45° field of view. Image size 2212x1659:
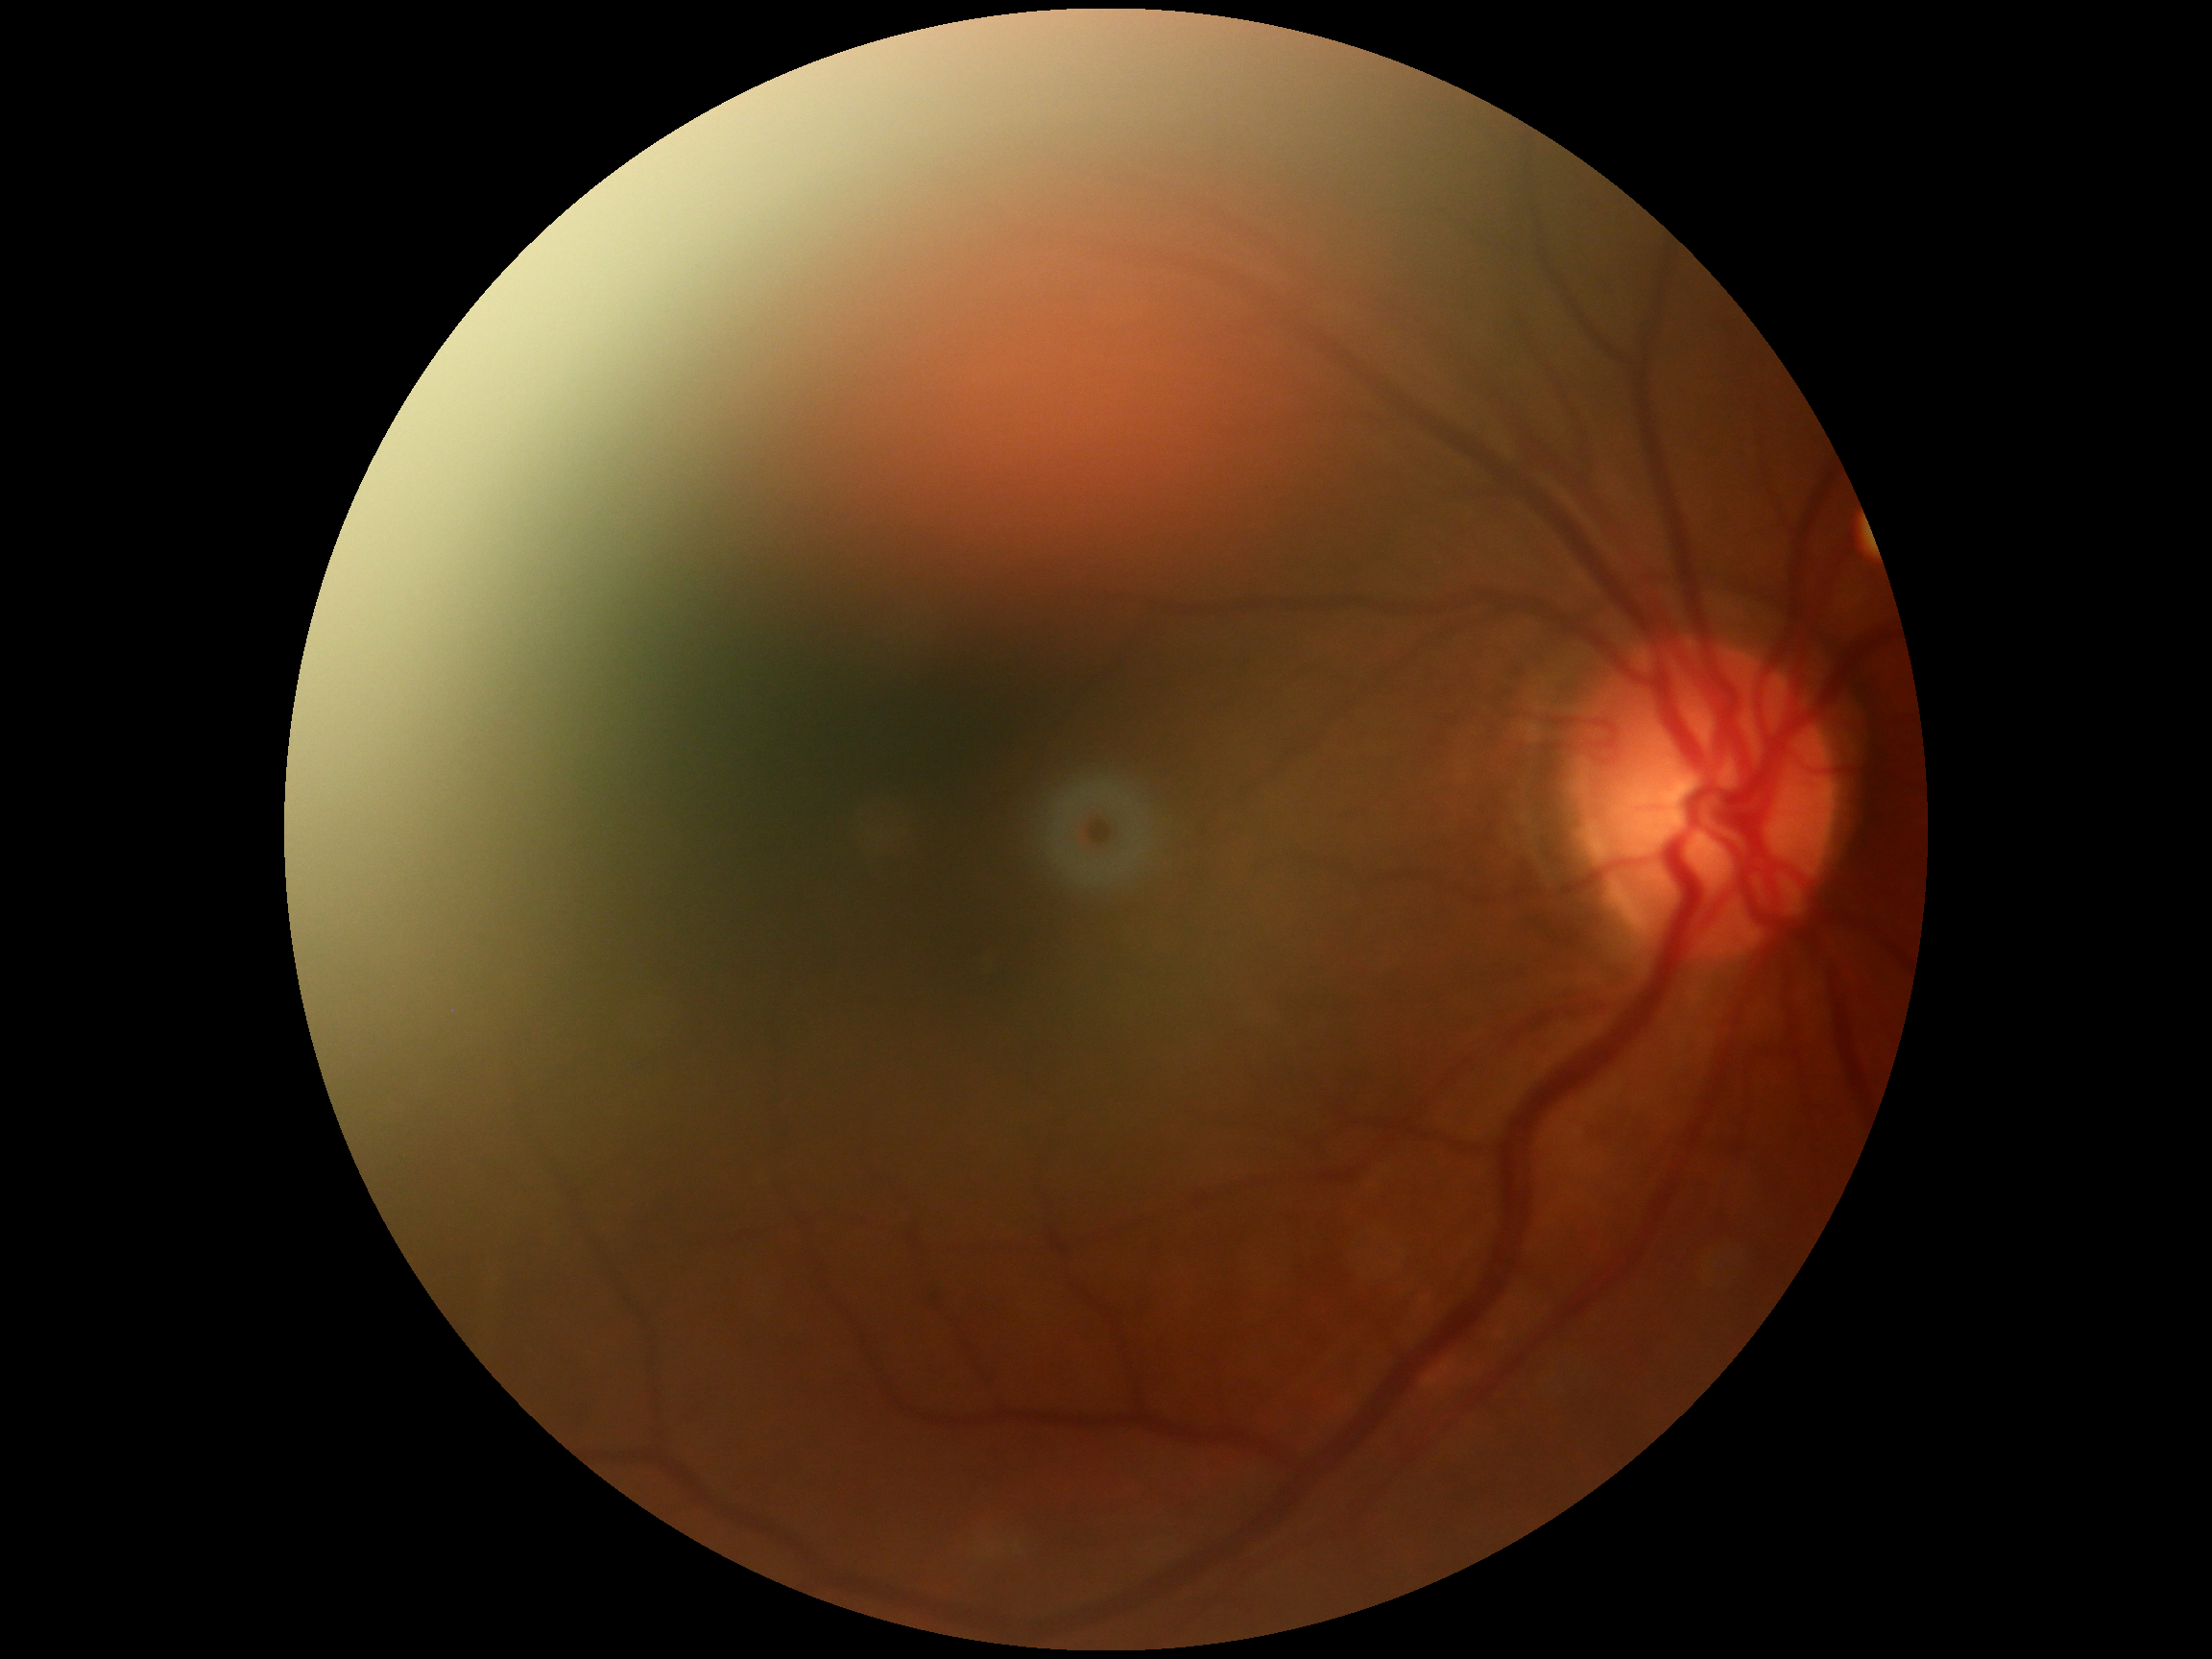 DR severity: no apparent diabetic retinopathy (grade 0).
No DR findings.